848 x 848 pixels, NIDEK AFC-230:
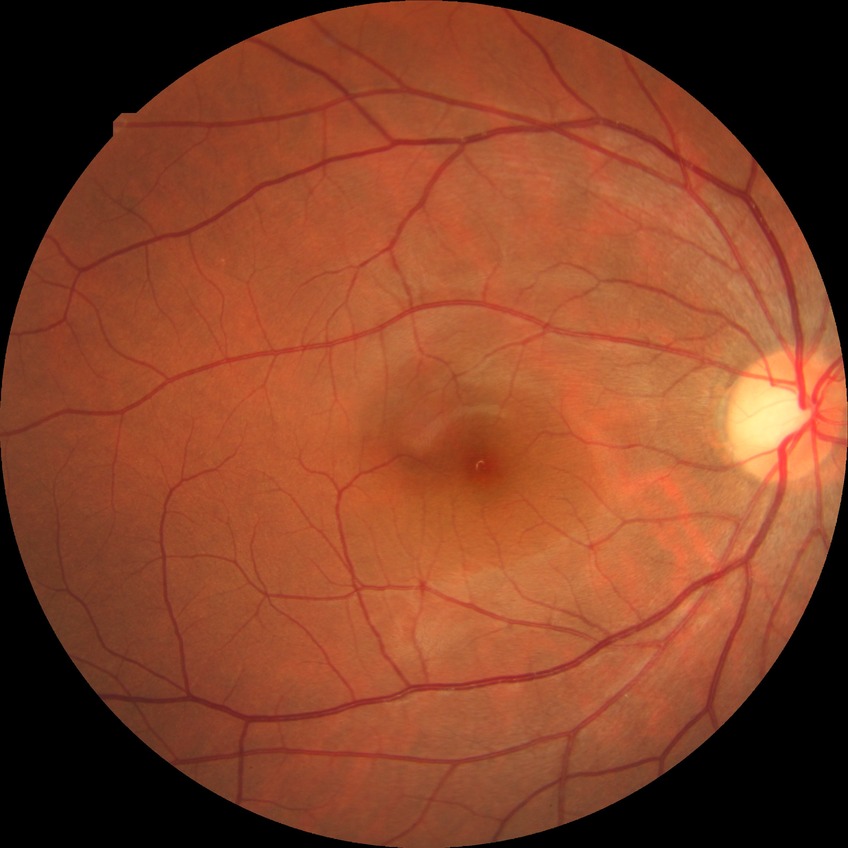
diabetic retinopathy grade: no diabetic retinopathy.